2048 by 1536 pixels · retinal fundus photograph
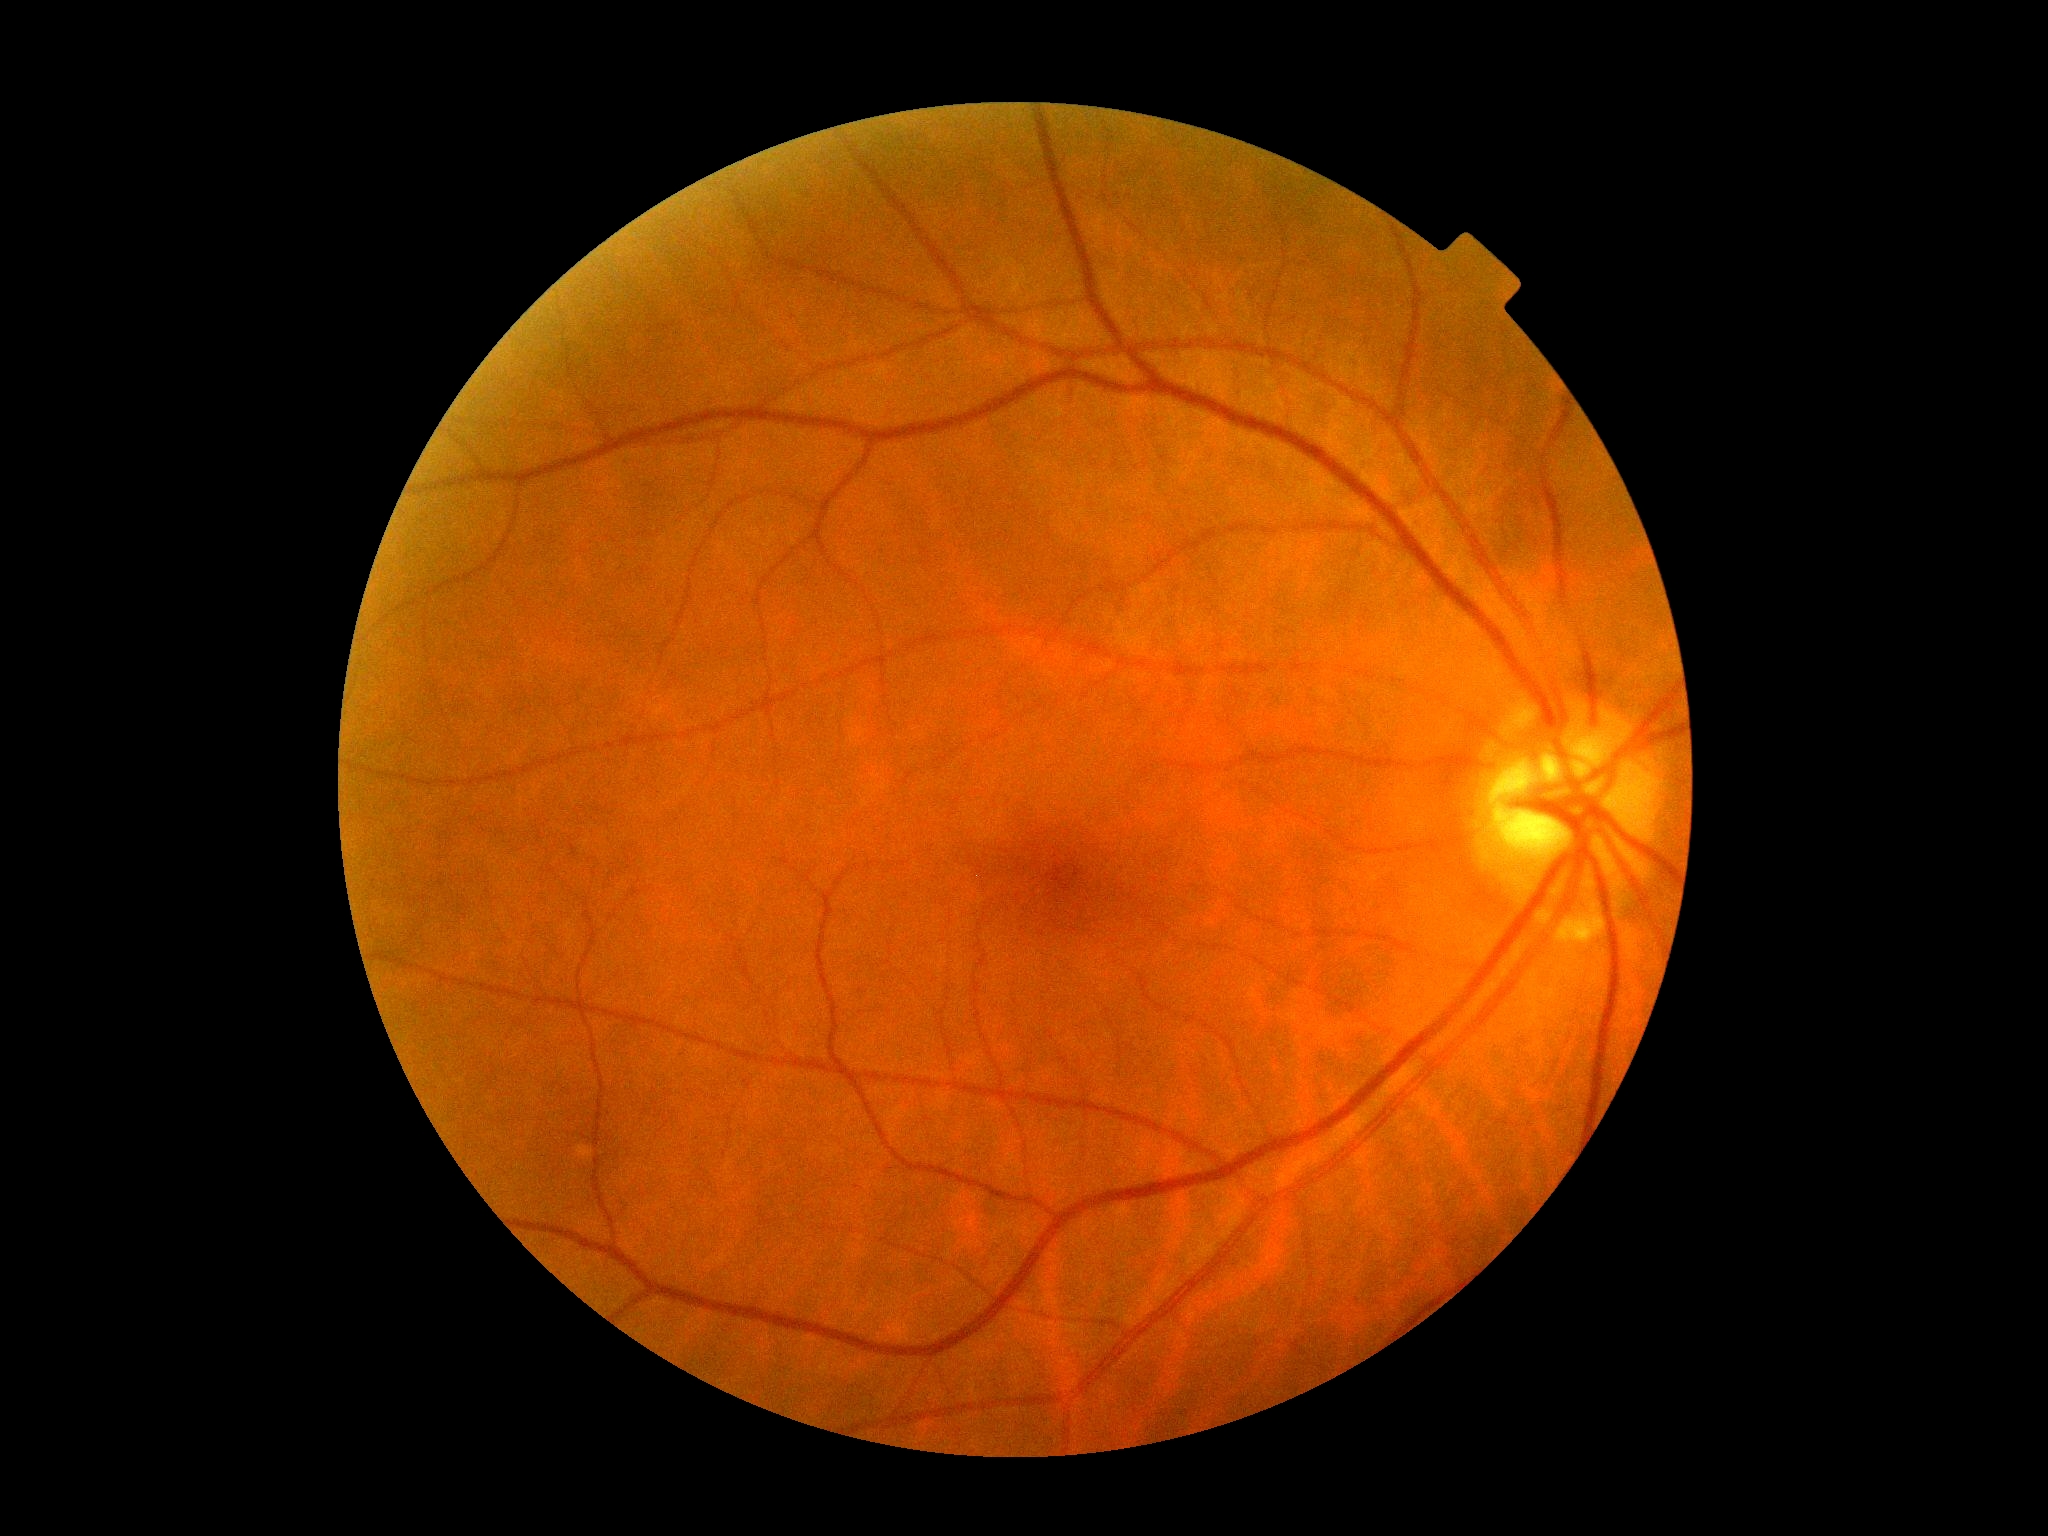
Retinopathy is grade 0.